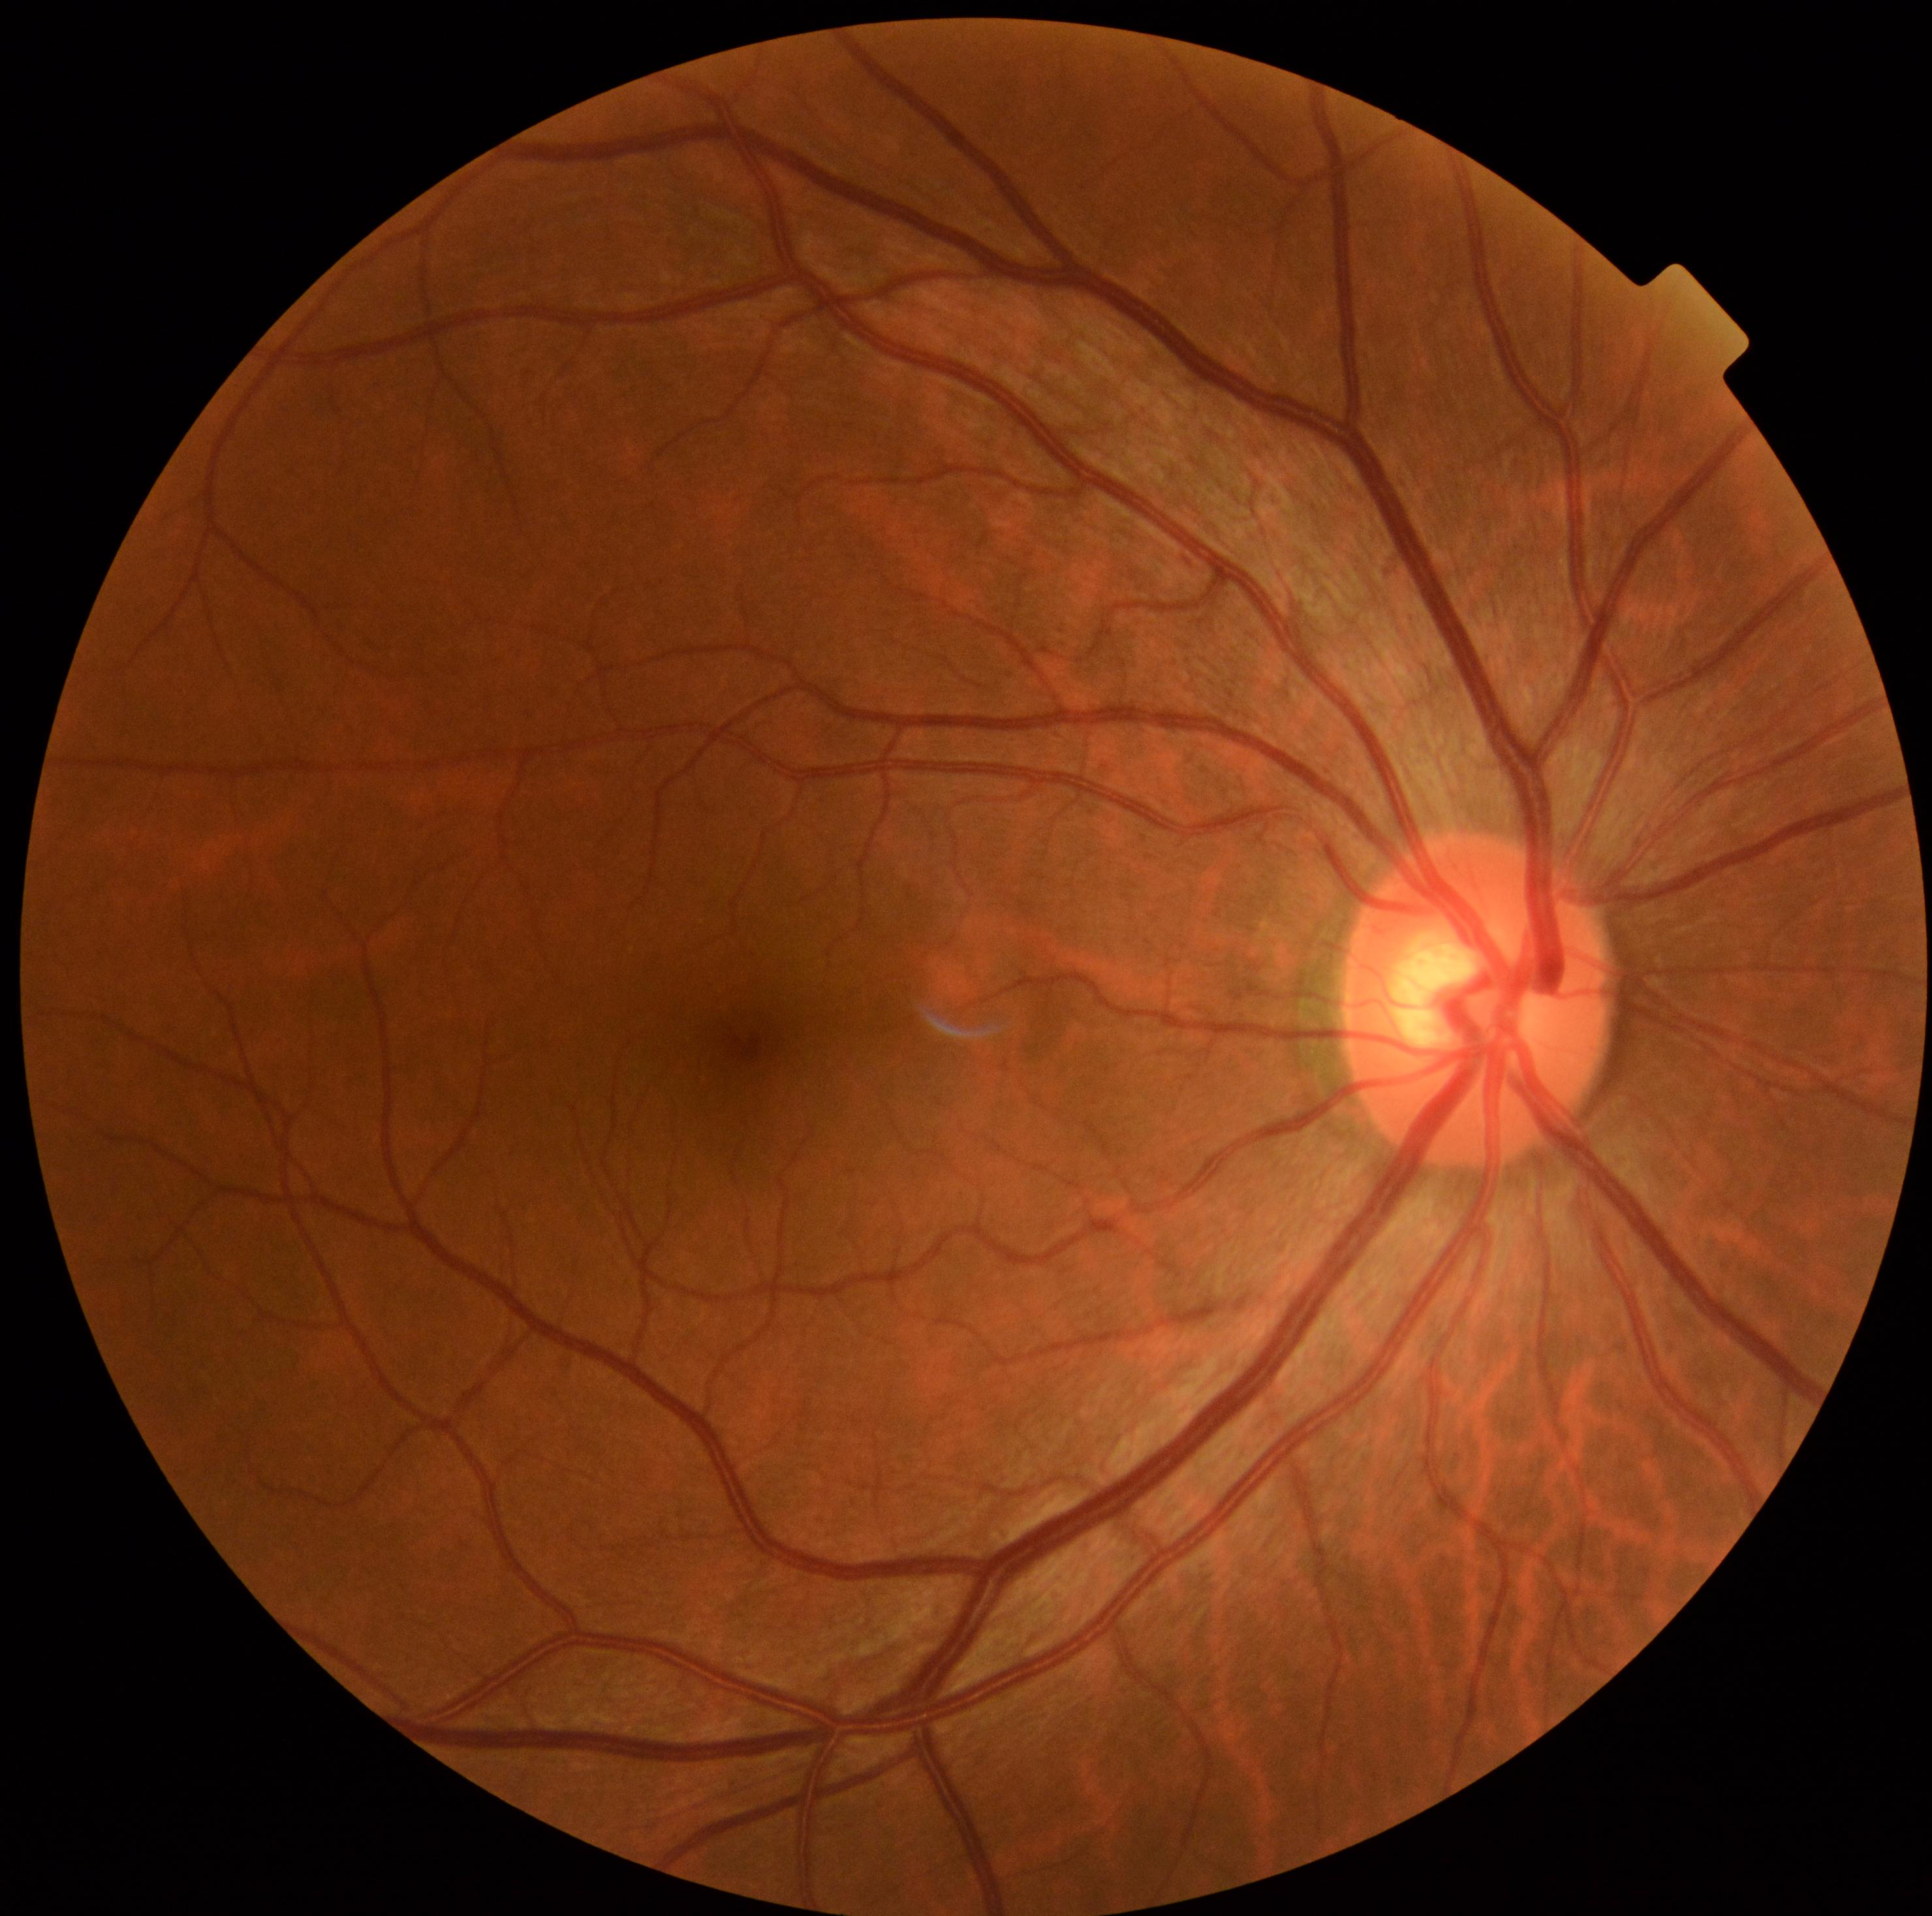
Retinopathy is grade 0 (no apparent retinopathy).